Color fundus image.
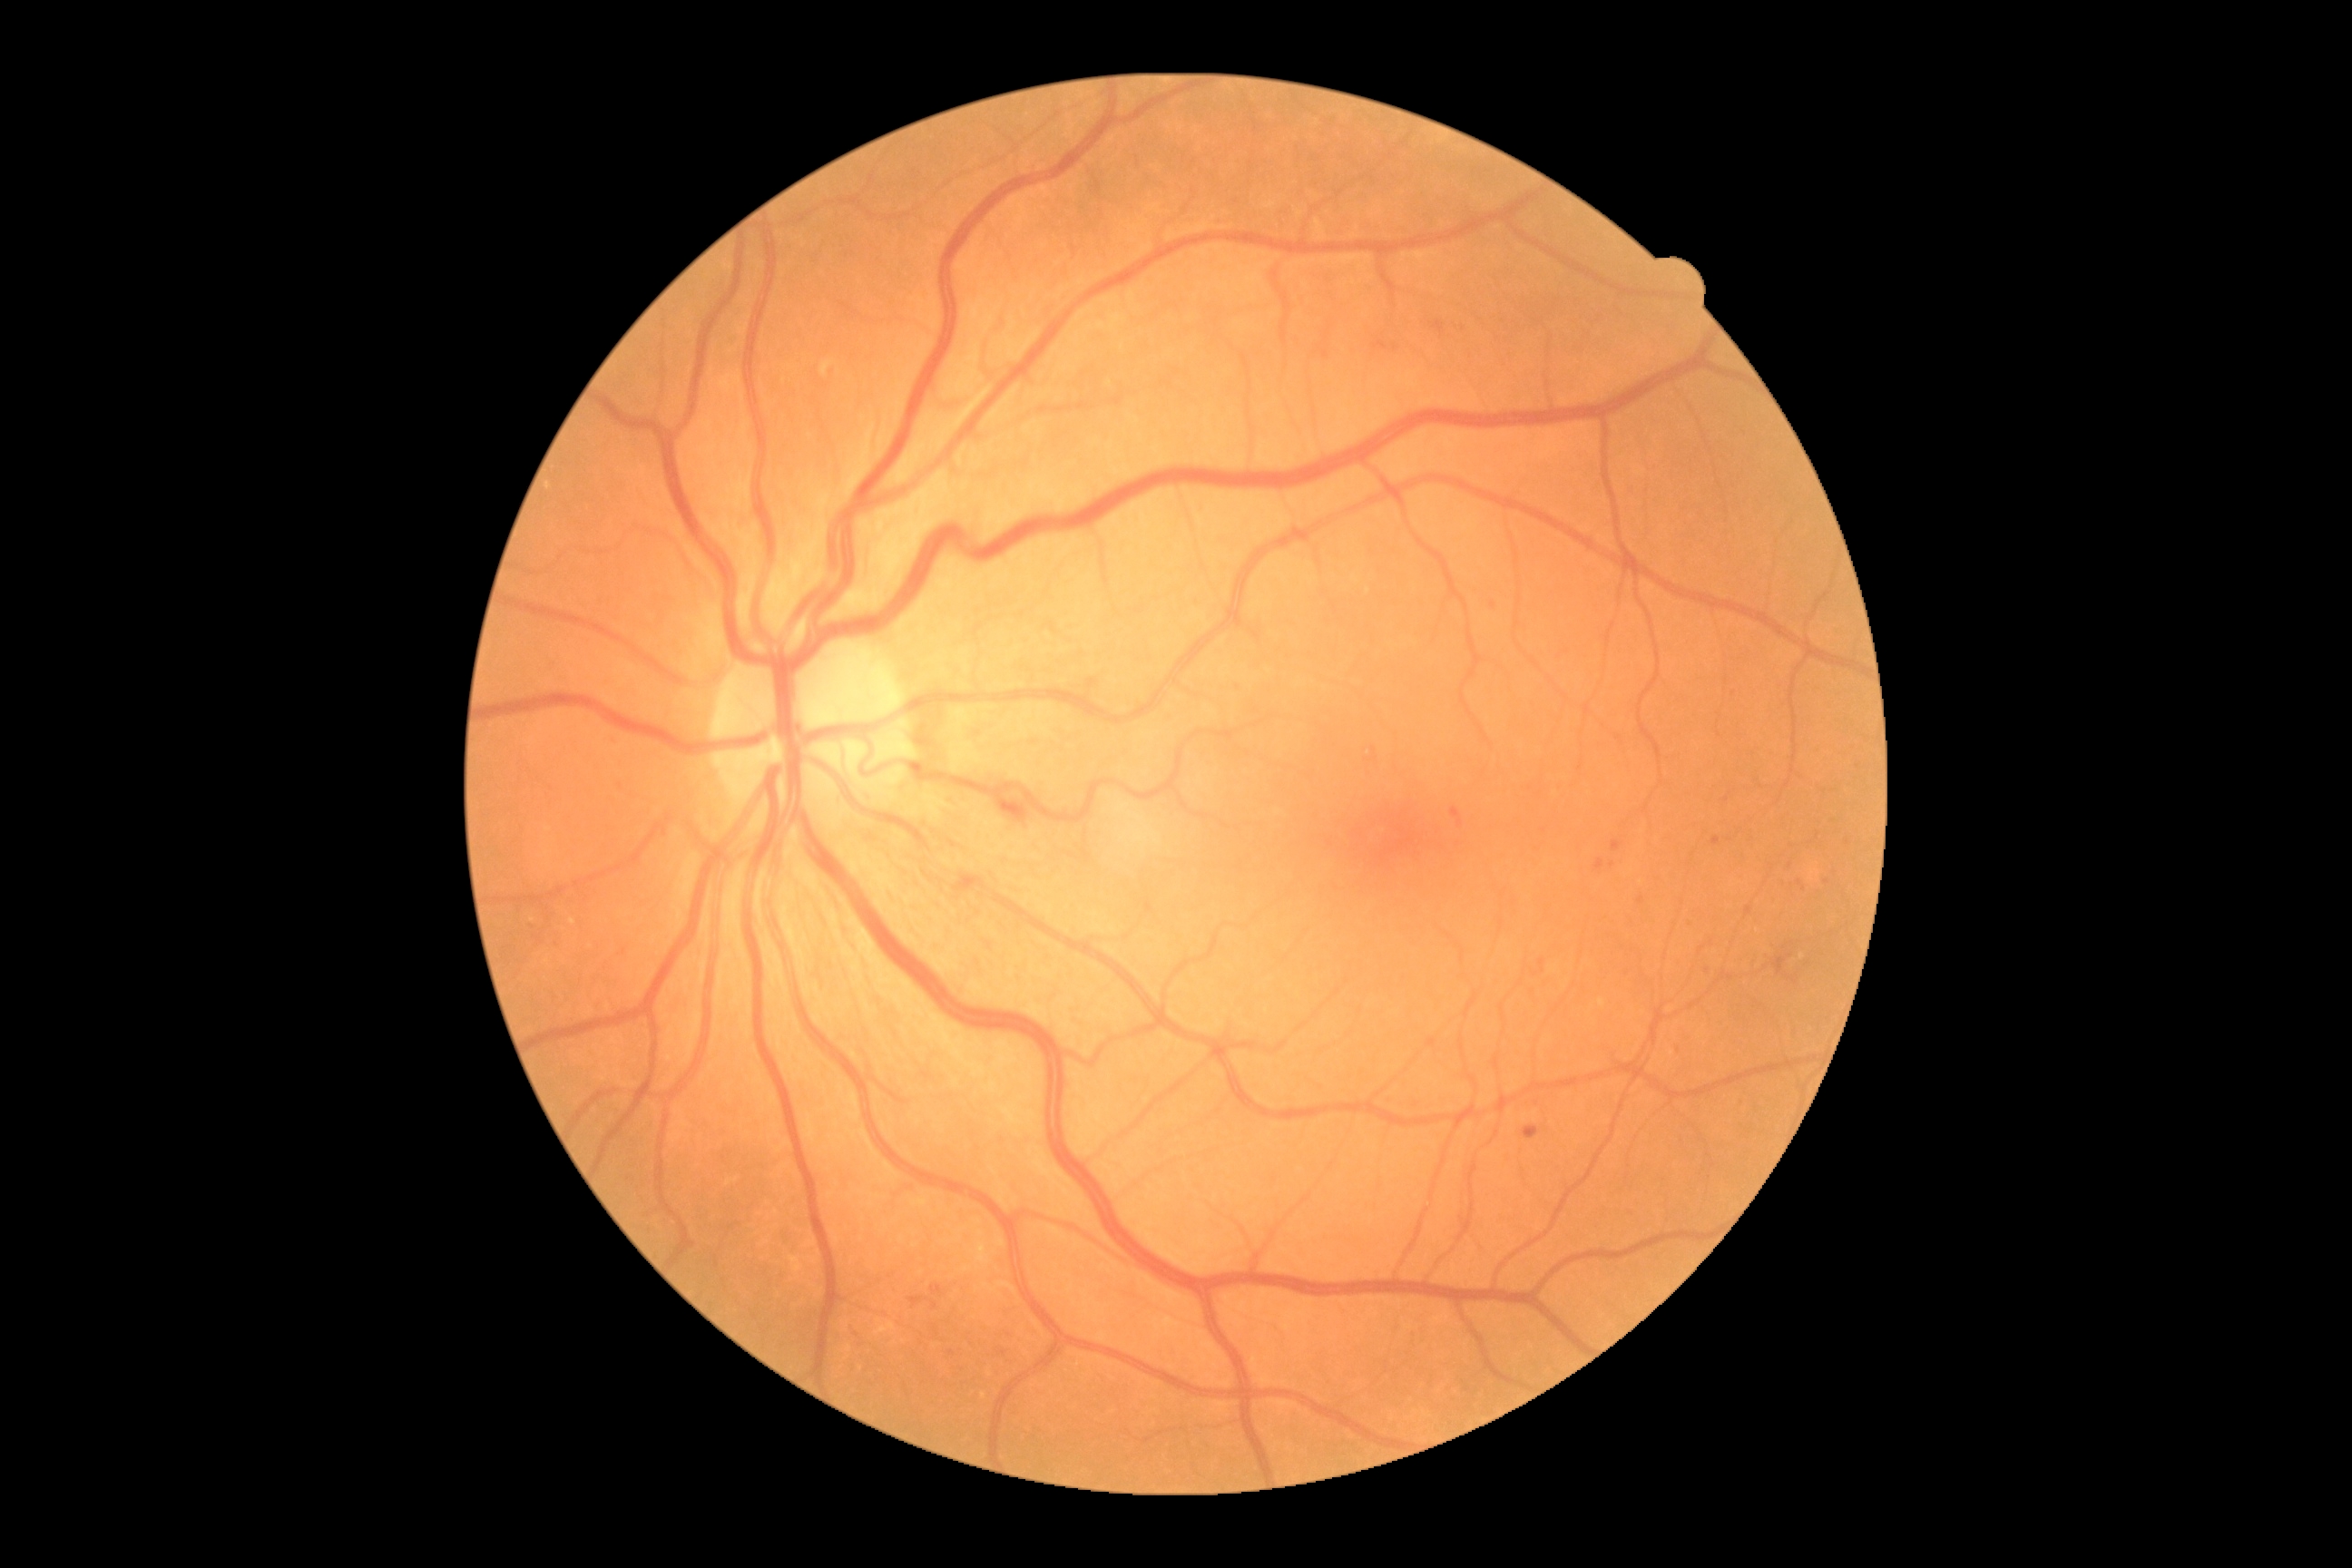

DR severity=grade 2 (moderate NPDR).